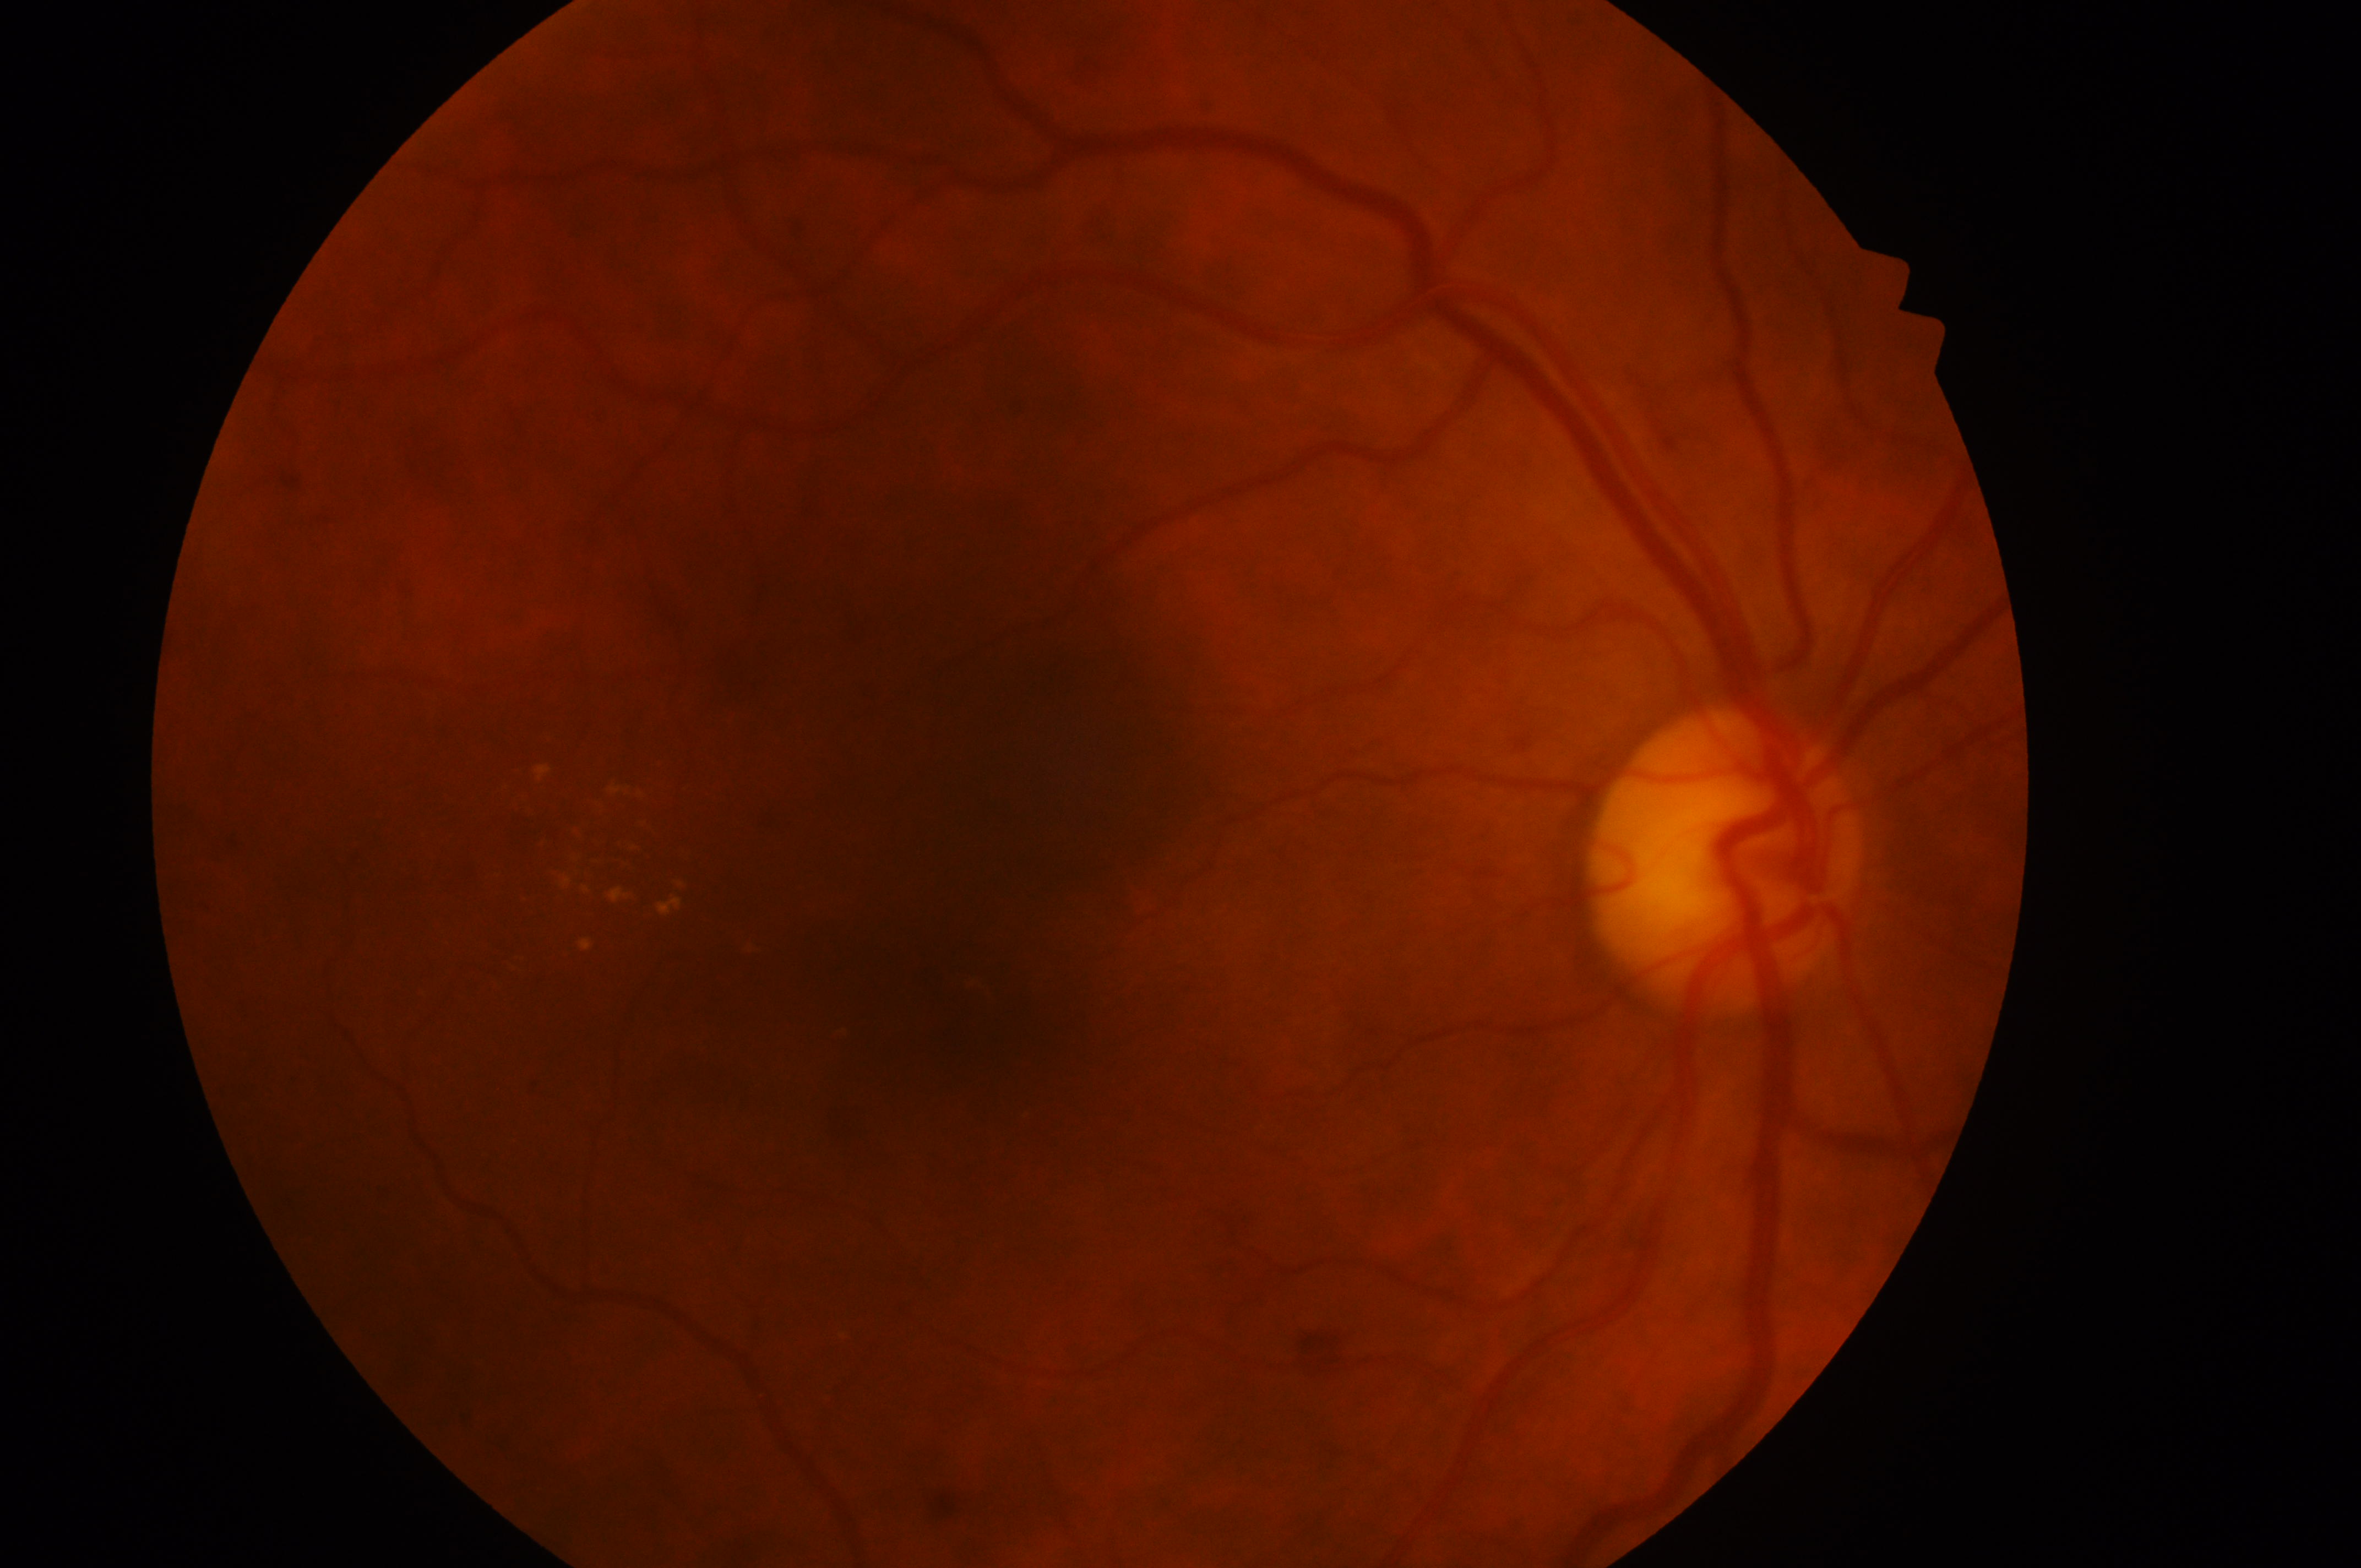

The fovea is at (x: 957, y: 1022). Diabetic retinopathy grade is 2 (moderate NPDR). Diabetic macular edema is grade 2 (high risk). The ONH is at (x: 1716, y: 872). Imaged eye: right eye.